Fundus photo — 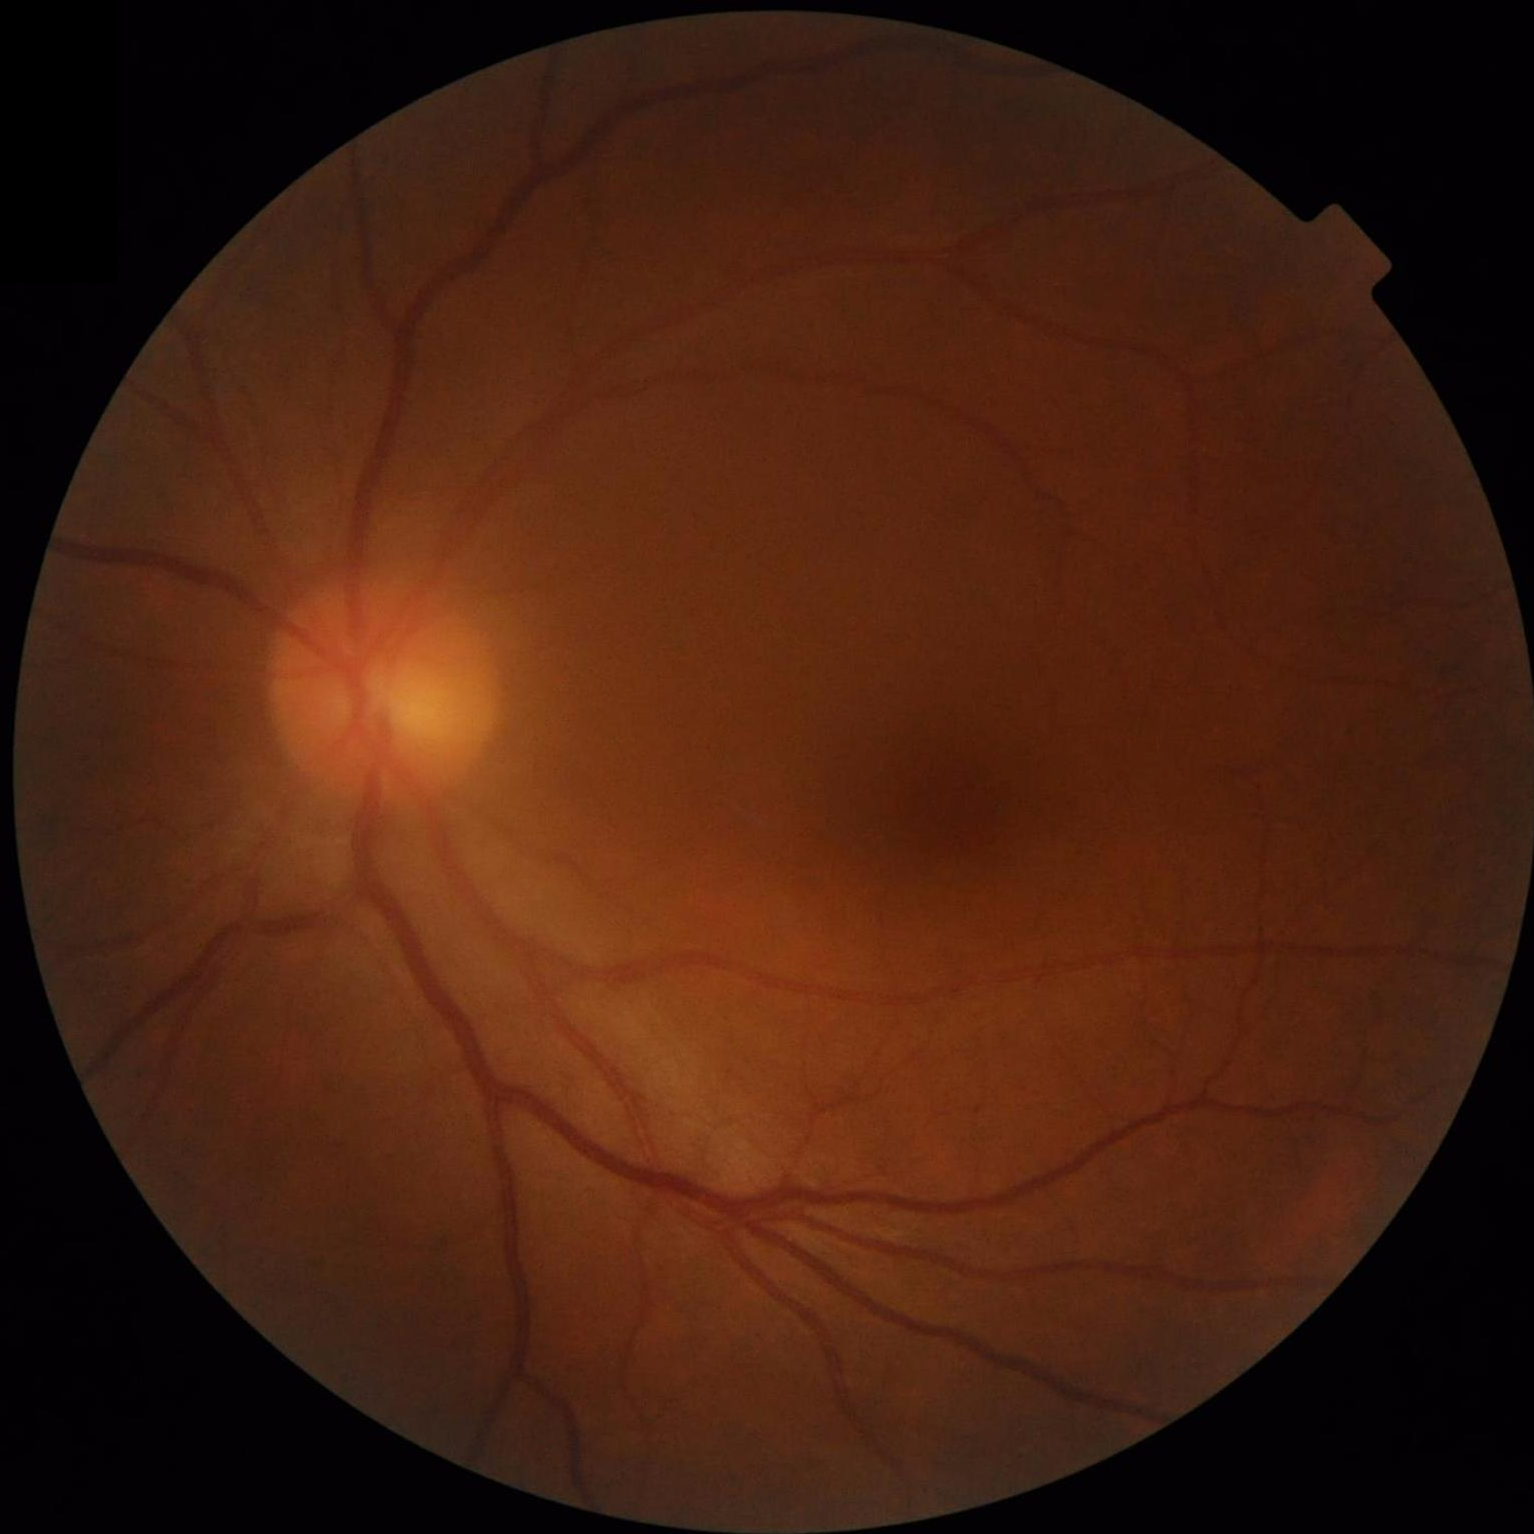

Image quality is adequate for diagnostic use. No over- or under-exposure. Vessels and details are readily distinguishable.